Pediatric retinal photograph (wide-field). Image size 1440x1080:
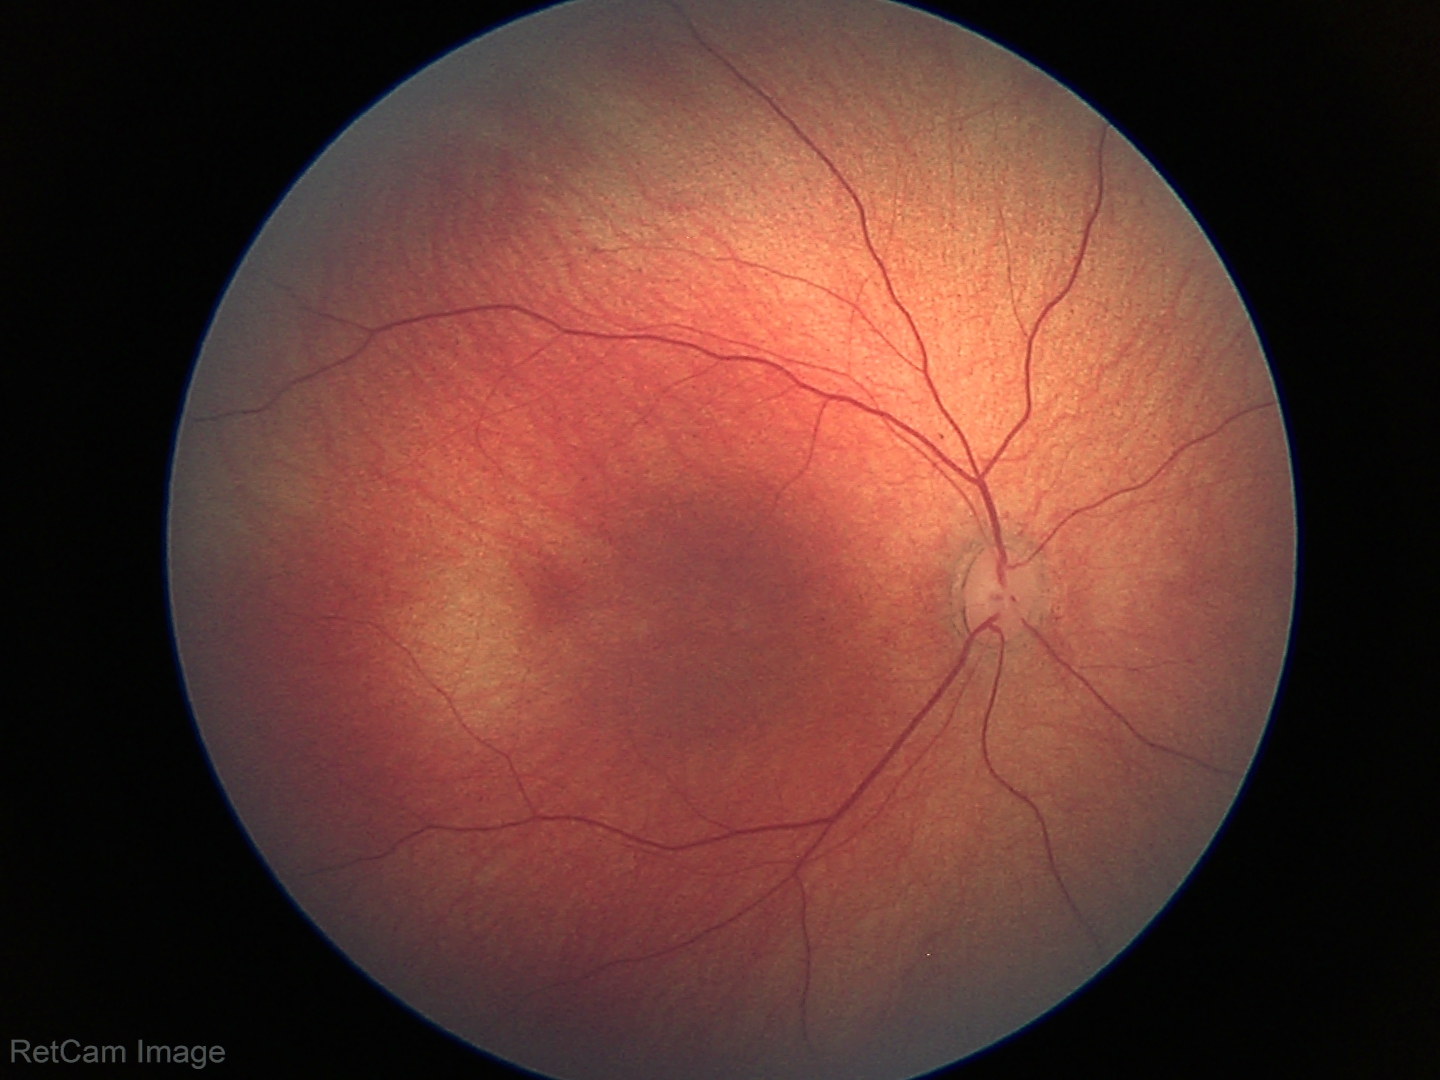

Impression: no pathology identified.